Pediatric retinal photograph (wide-field); image size 1440x1080; acquired on the Natus RetCam Envision.
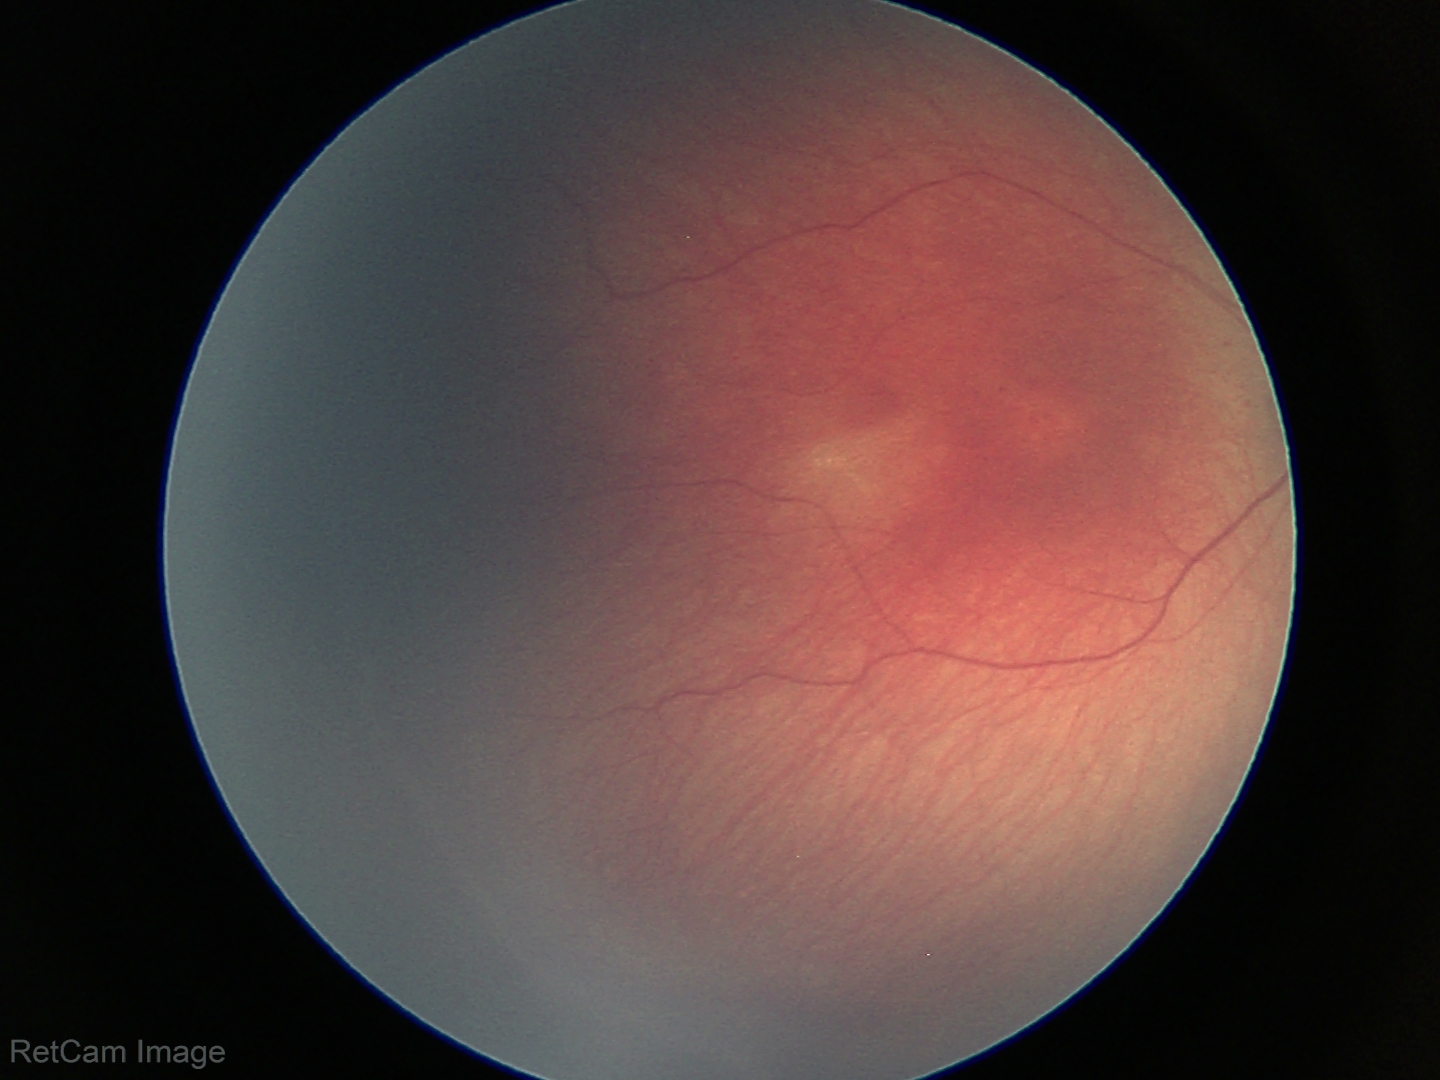
Retinopathy of prematurity: stage 2
plus form: absent